45° field of view.
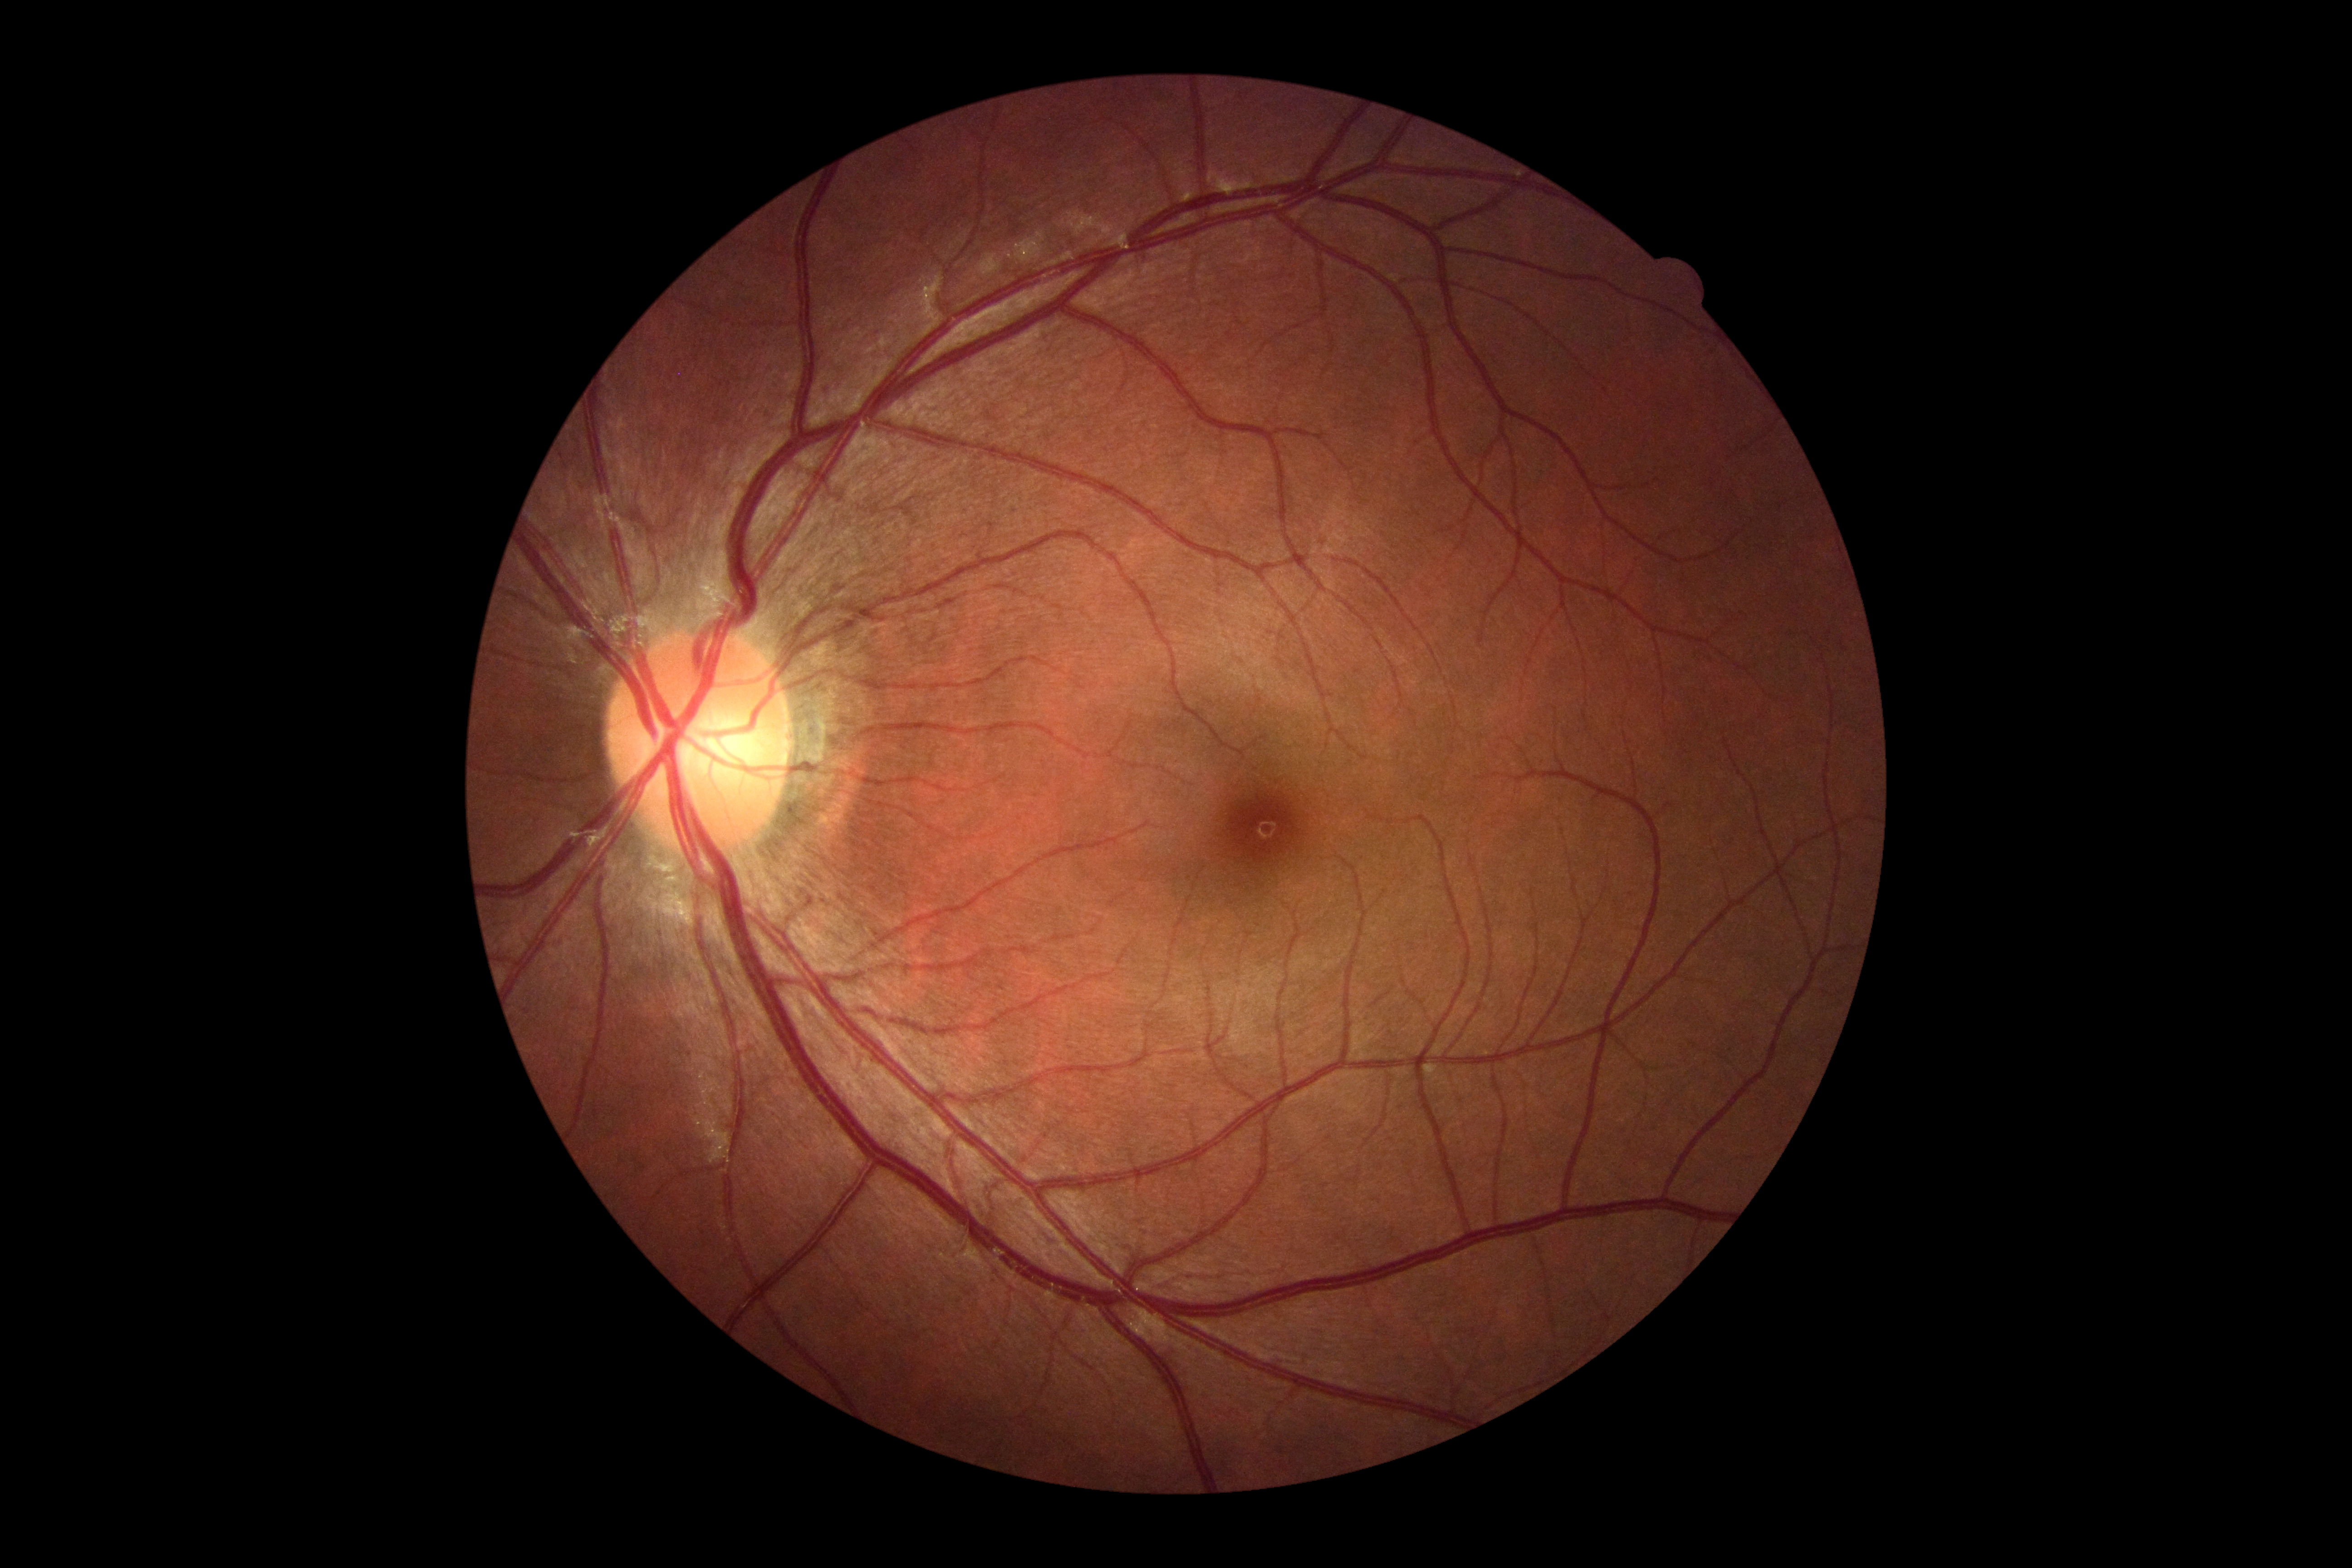 DR severity = 0